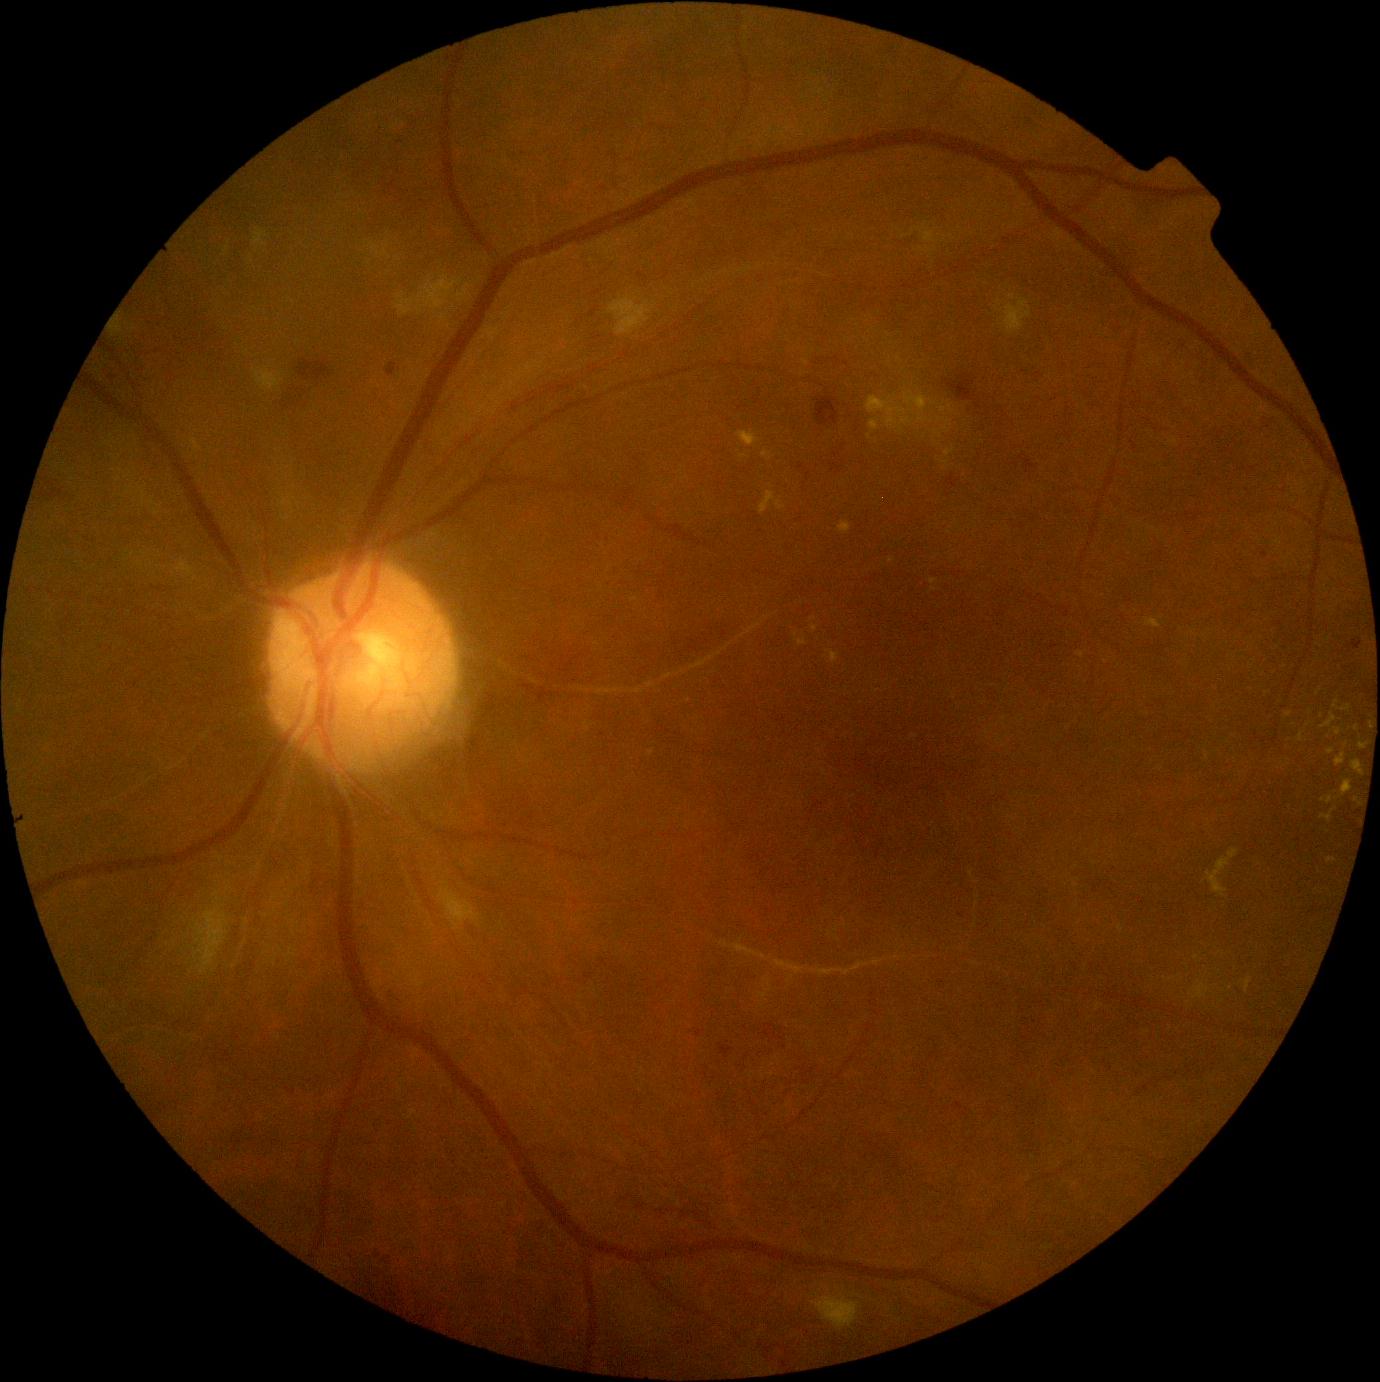
- retinopathy grade — 2 (moderate NPDR)